1240 x 1240 pixels; wide-field fundus image from infant ROP screening.
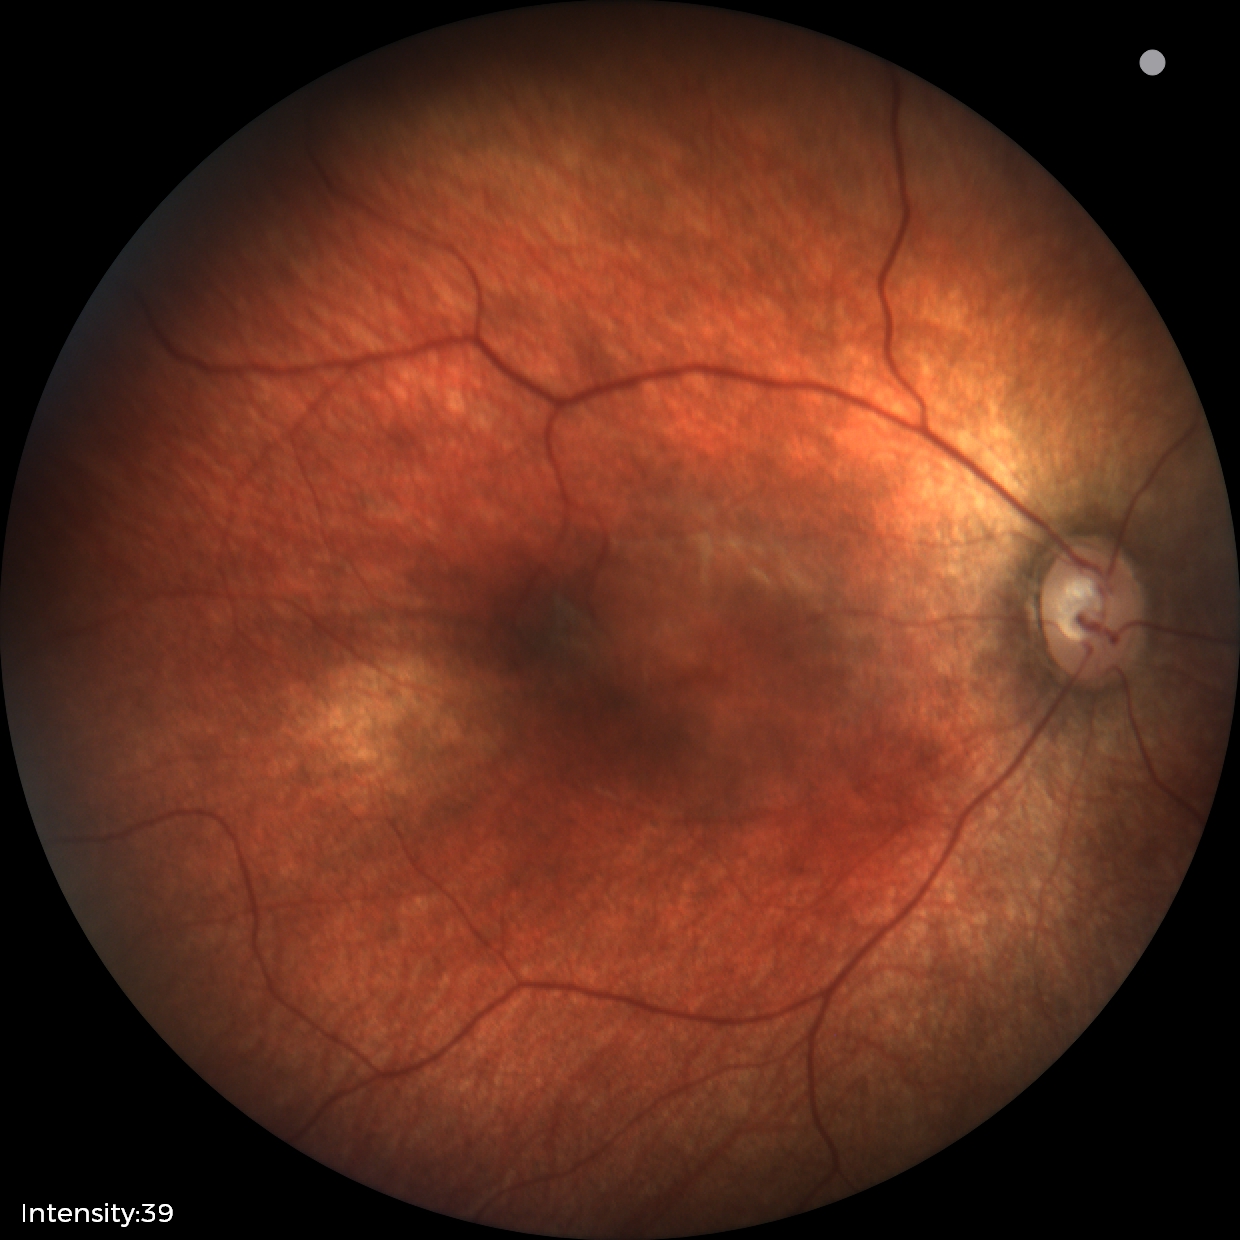 Screening diagnosis: physiological.